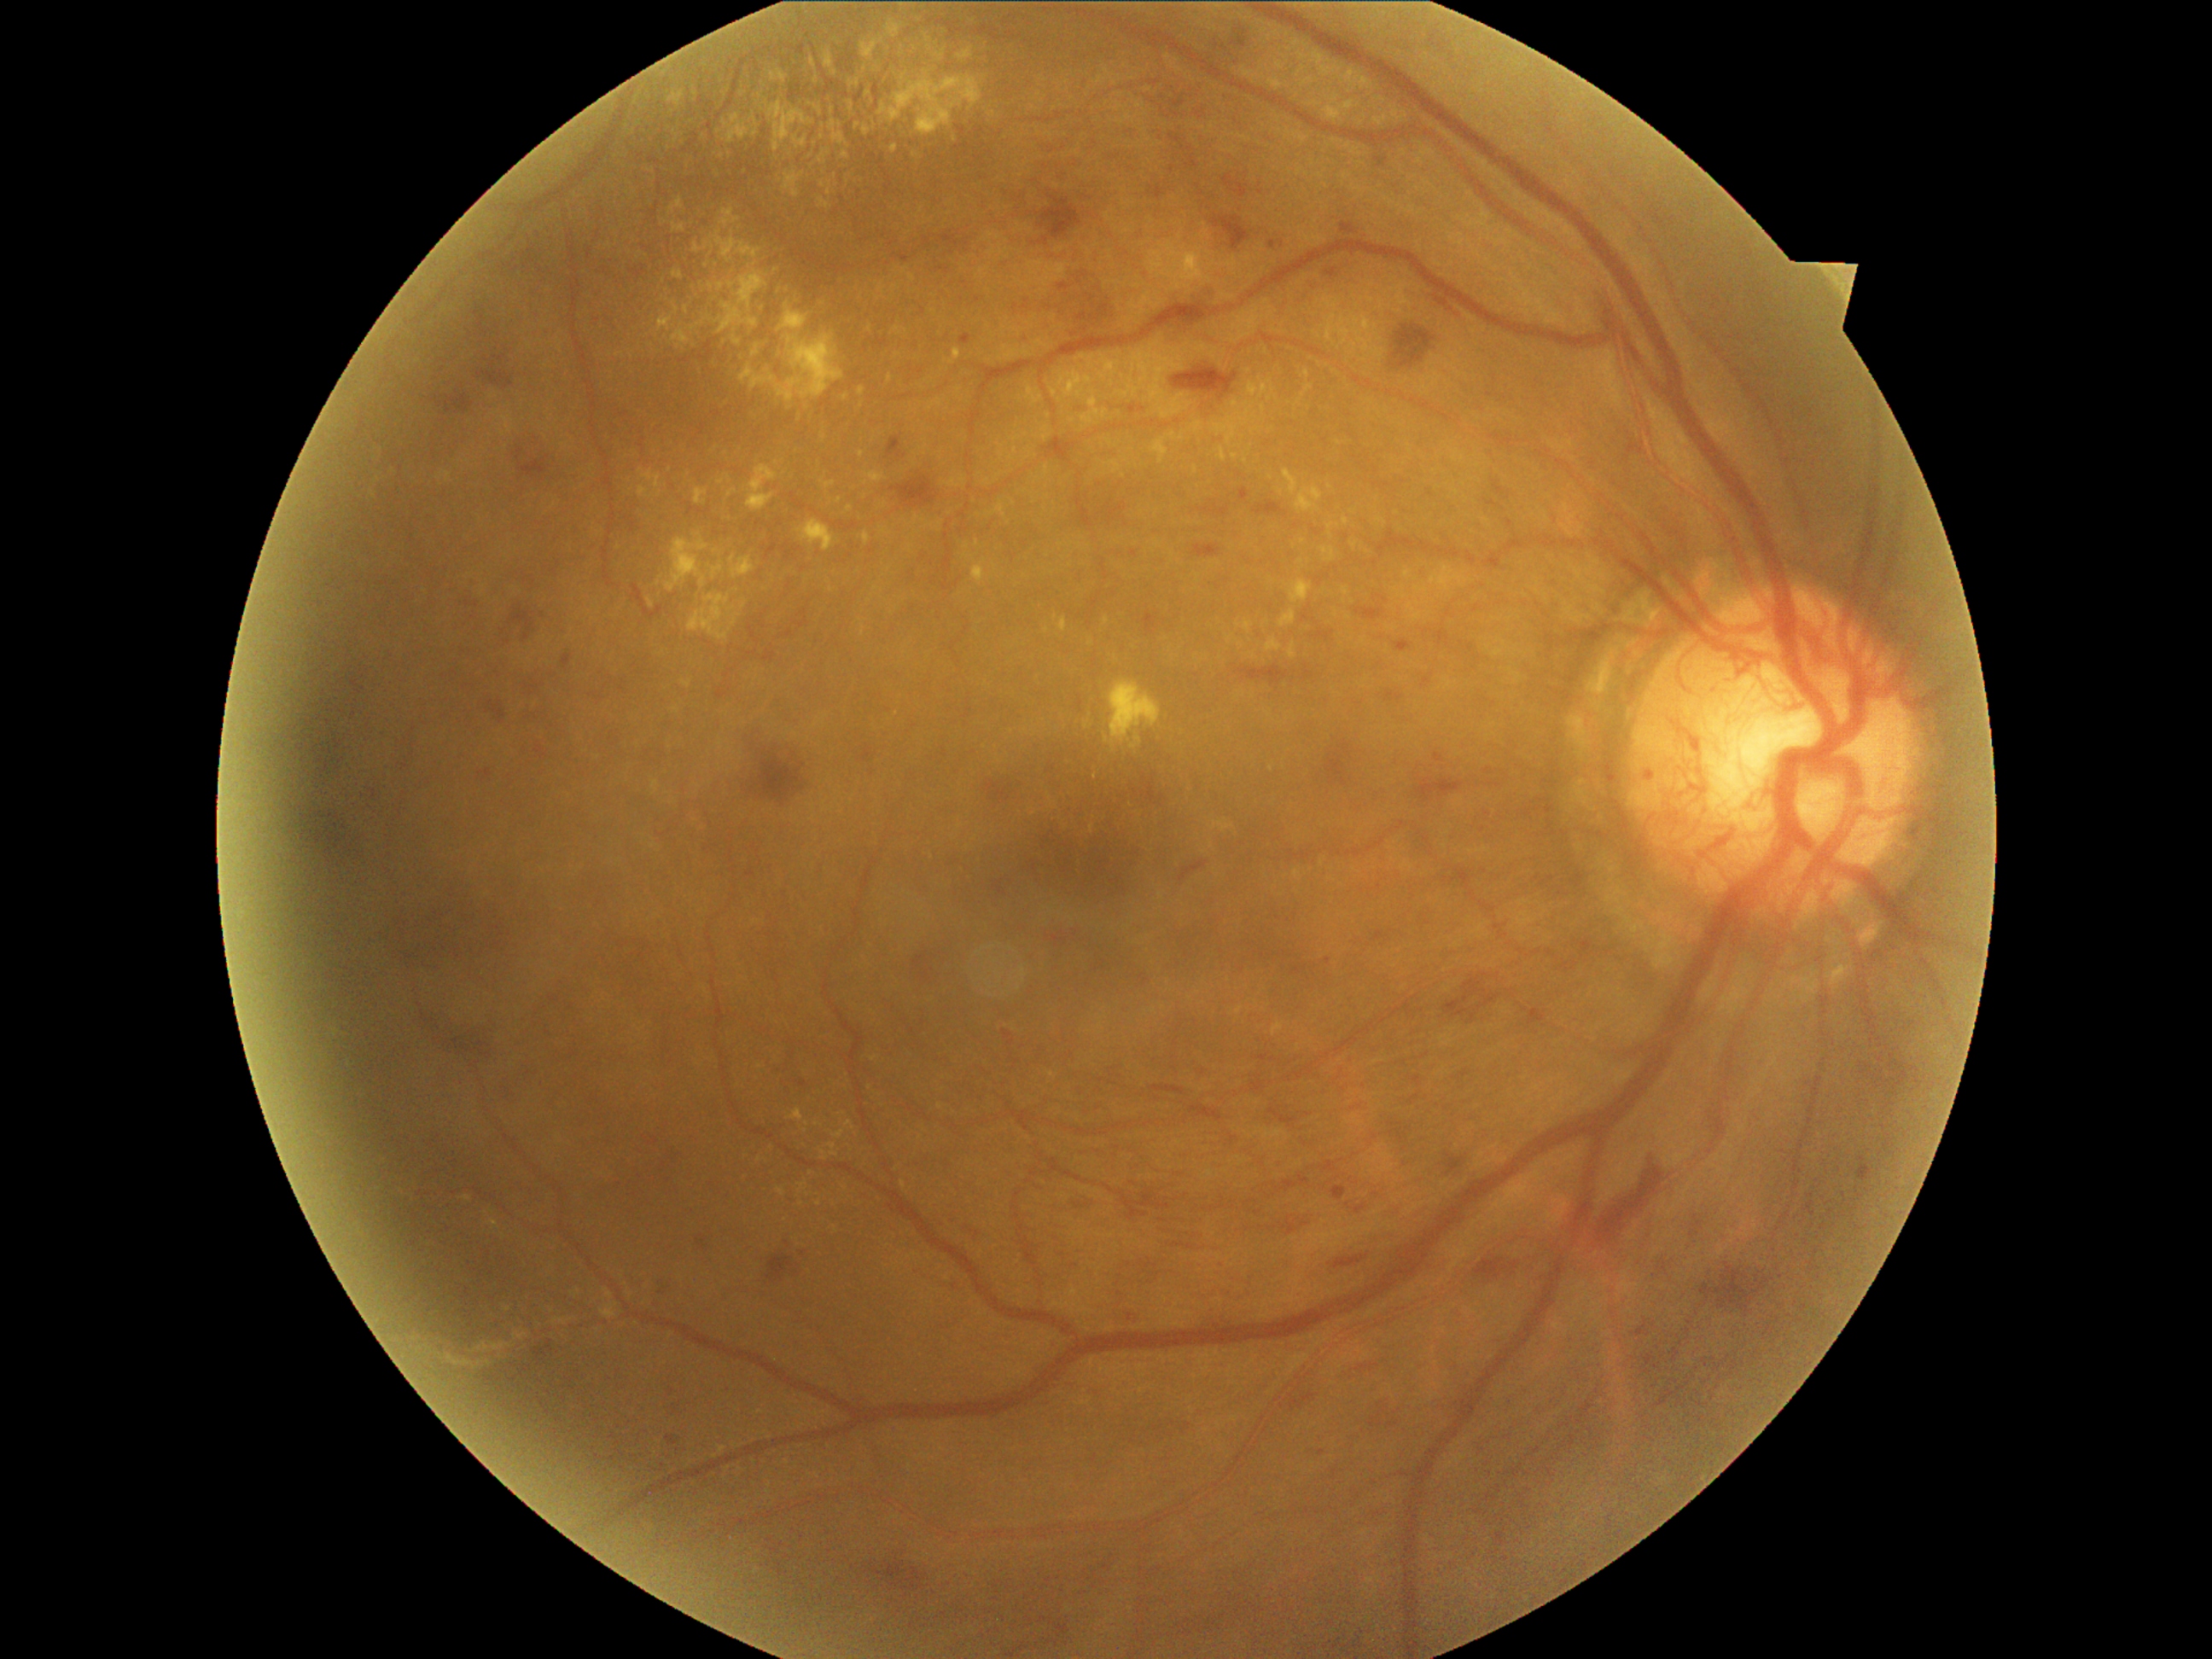 partial: true
dr_grade: 4
dr_grade_name: PDR
lesions:
  he:
    - region(405, 883, 504, 960)
    - region(952, 1221, 977, 1237)
    - region(1293, 965, 1308, 975)
    - region(1127, 1308, 1143, 1325)
    - region(1388, 1421, 1400, 1428)
    - region(306, 714, 332, 728)
    - region(1172, 1238, 1221, 1254)
    - region(509, 605, 537, 641)
    - region(433, 1016, 501, 1054)
    - region(1476, 1257, 1520, 1283)
    - region(748, 747, 806, 806)
    - region(317, 730, 325, 735)
    - region(1269, 1107, 1298, 1126)
    - region(868, 1559, 926, 1592)
    - region(919, 969, 933, 981)
    - region(1194, 544, 1221, 559)
  he_small_centers:
    - (337,691)
  se: []
  ma:
    - region(1240, 489, 1249, 503)
    - region(747, 871, 755, 878)
    - region(798, 1080, 806, 1086)
    - region(667, 1435, 677, 1447)
    - region(1341, 224, 1358, 236)
    - region(562, 655, 573, 670)
    - region(1269, 242, 1276, 250)
    - region(1126, 1312, 1141, 1324)
    - region(1395, 639, 1411, 651)
    - region(1332, 1187, 1346, 1201)
    - region(537, 748, 547, 759)
    - region(1436, 750, 1447, 762)
    - region(697, 1235, 707, 1249)
    - region(1325, 269, 1337, 279)
    - region(480, 769, 492, 781)
    - region(960, 335, 972, 346)
  ma_small_centers:
    - (671,1391)
    - (1284,245)
  ex:
    - region(602, 1303, 619, 1318)
    - region(849, 79, 861, 88)
    - region(834, 1131, 844, 1139)
    - region(730, 556, 755, 579)
    - region(682, 682, 692, 689)
    - region(878, 284, 883, 293)
    - region(1151, 431, 1185, 463)
    - region(728, 282, 736, 289)
    - region(740, 303, 844, 404)
    - region(1301, 78, 1317, 88)
    - region(824, 52, 837, 78)
    - region(1059, 383, 1068, 407)
    - region(1377, 98, 1387, 103)
    - region(834, 35, 846, 54)
    - region(752, 344, 760, 358)
  ex_small_centers:
    - (845,397)
    - (707,266)
    - (758,1159)
    - (488,1363)
    - (875,1058)